848x848; 45° FOV:
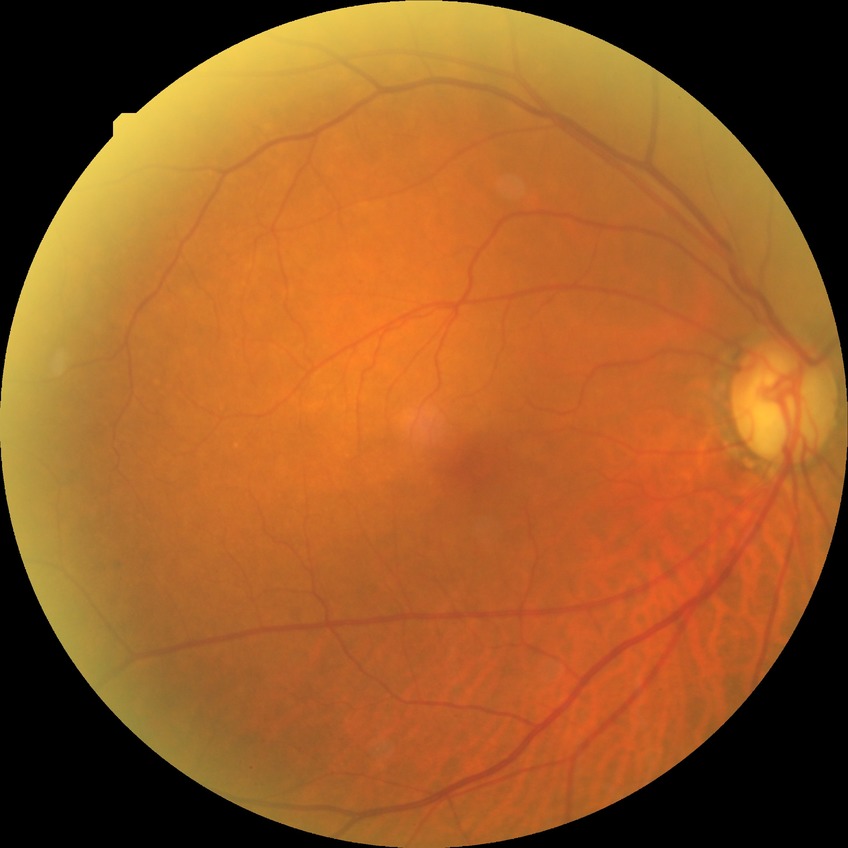 davis_grade: no diabetic retinopathy (NDR)